Color fundus image. 45° field of view.
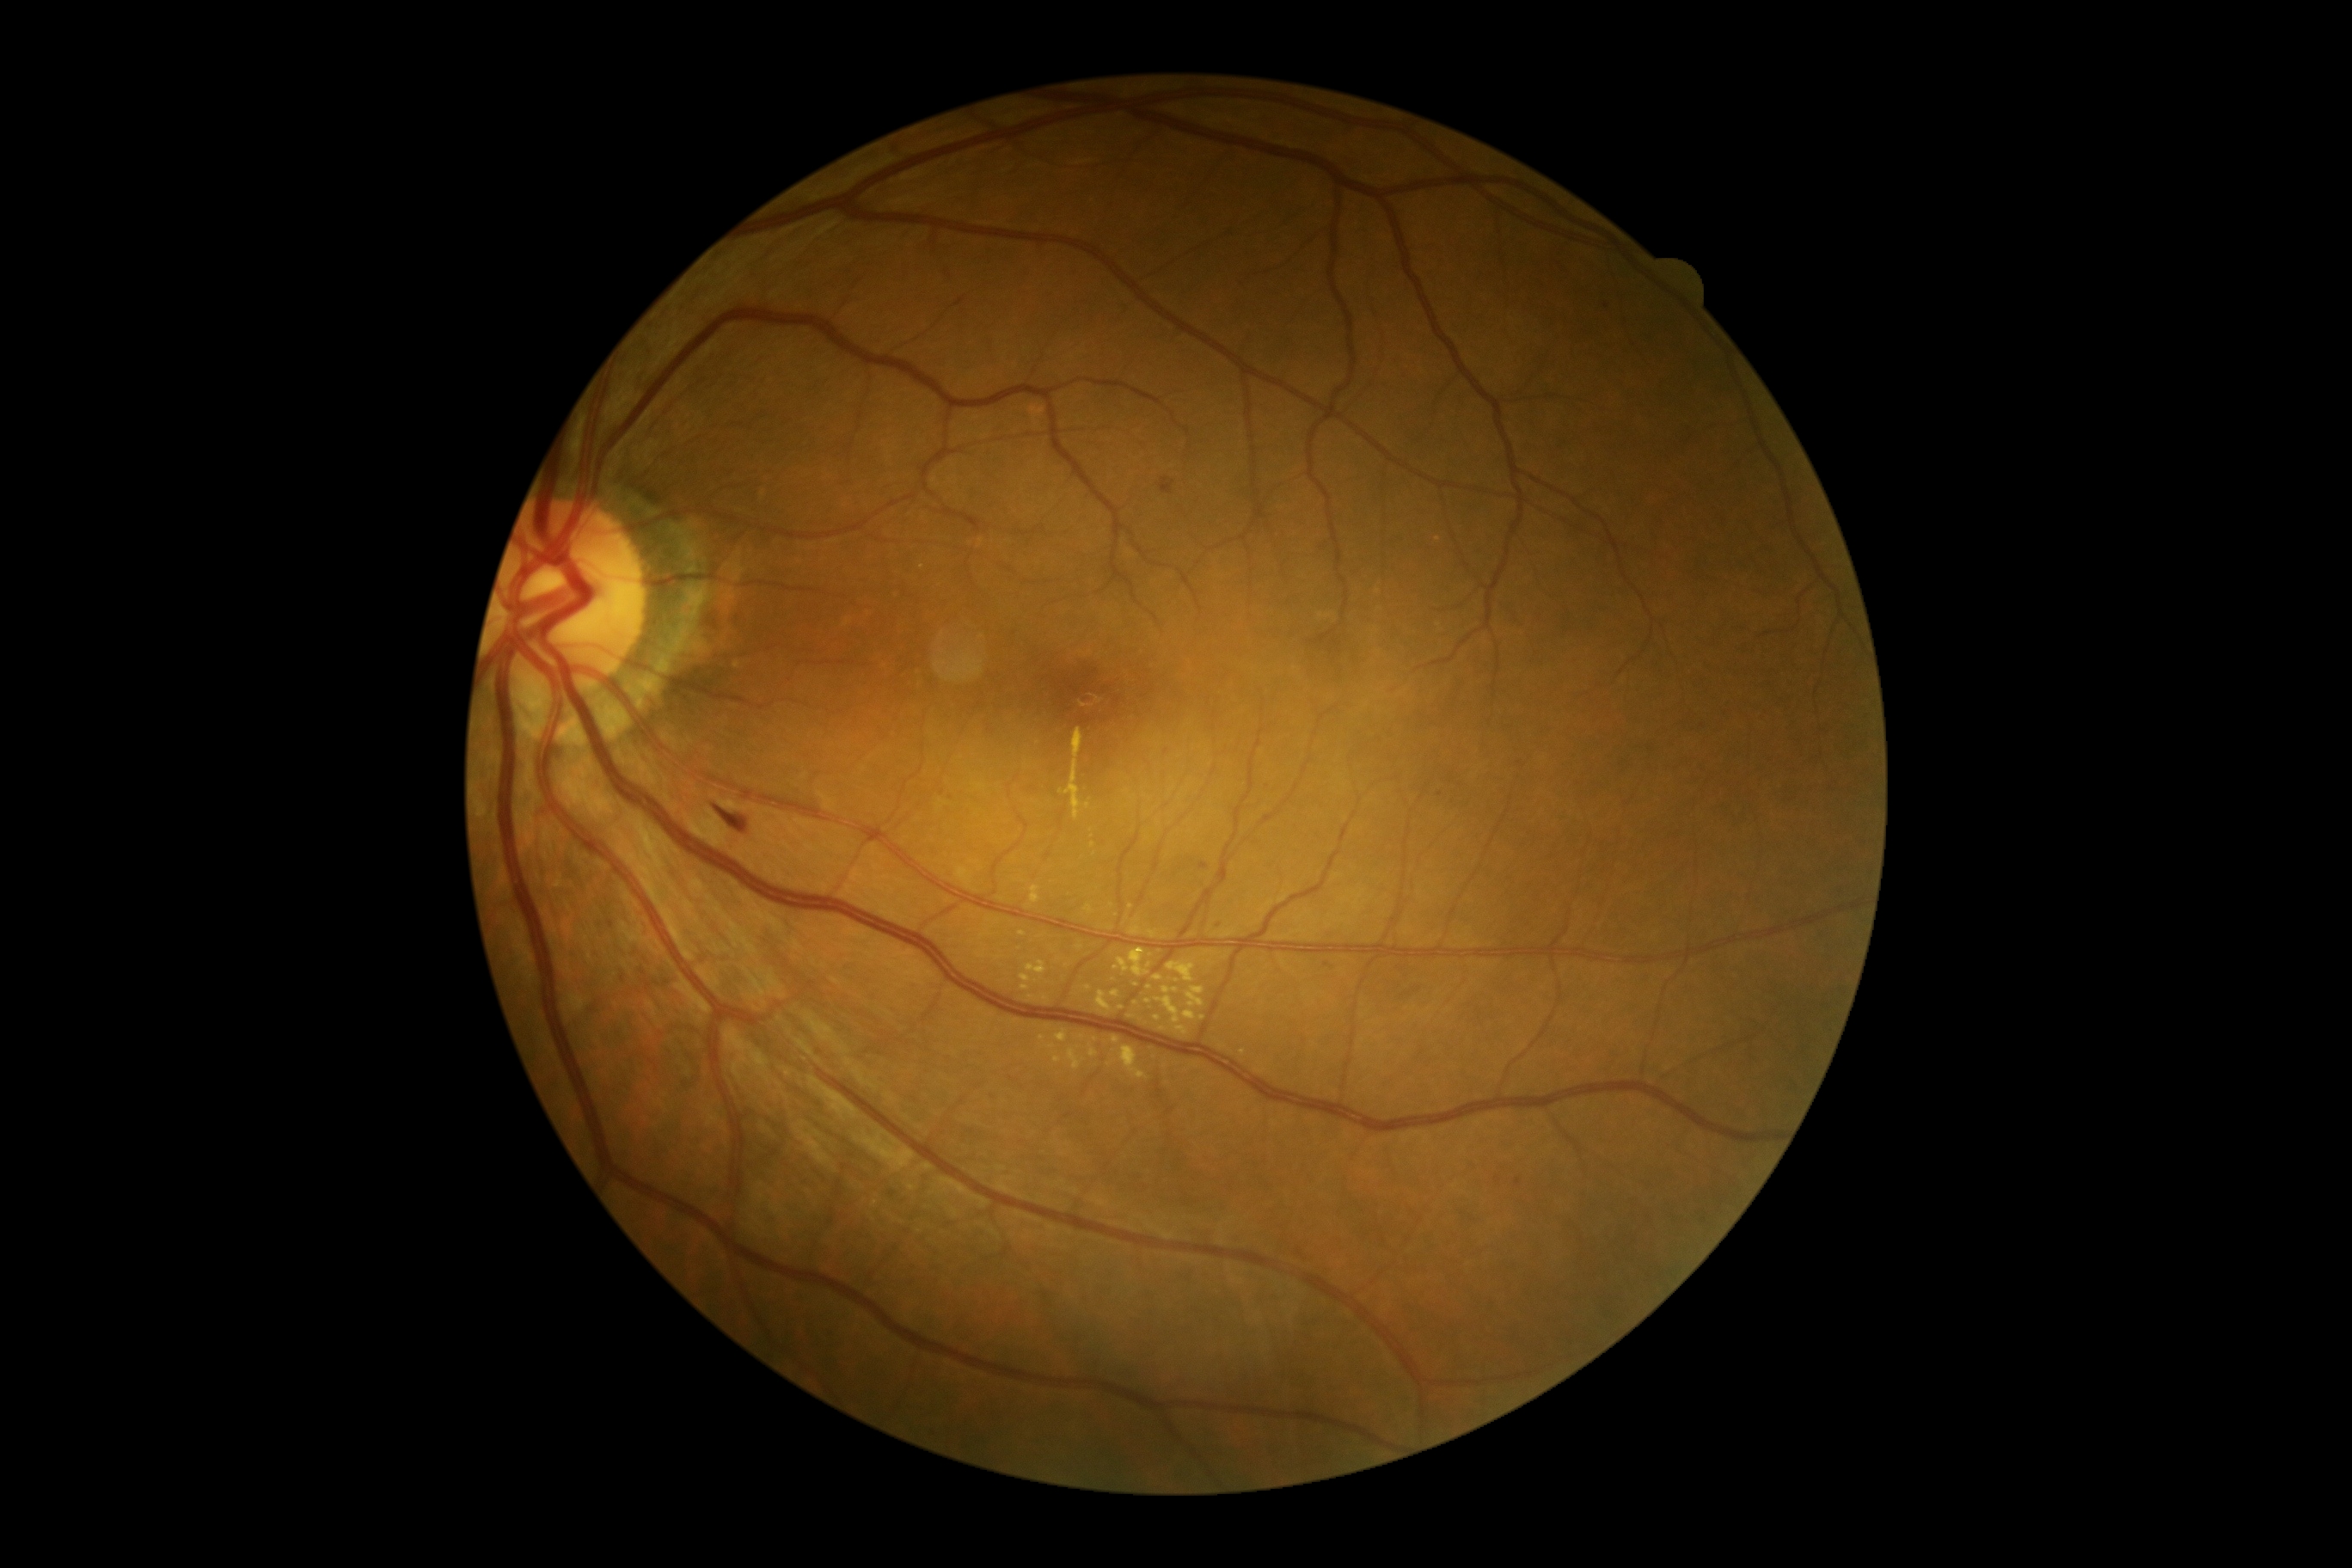 Diabetic retinopathy (DR) is 2 — more than just microaneurysms but less than severe NPDR; non-proliferative diabetic retinopathy
A subset of detected lesions:
hard exudates (EXs) (partial): 1024 962 1046 976 | 1084 903 1096 916 | 1118 948 1149 977 | 1163 988 1179 995 | 1155 976 1163 981 | 1039 1036 1062 1063 | 1130 917 1141 936
Smaller EXs around [1116,969] | [1088,988] | [1082,1037] | [1031,998] | [1115,994] | [1148,1002] | [1201,1017]